1240 x 1240 pixels. Wide-field fundus image from infant ROP screening: 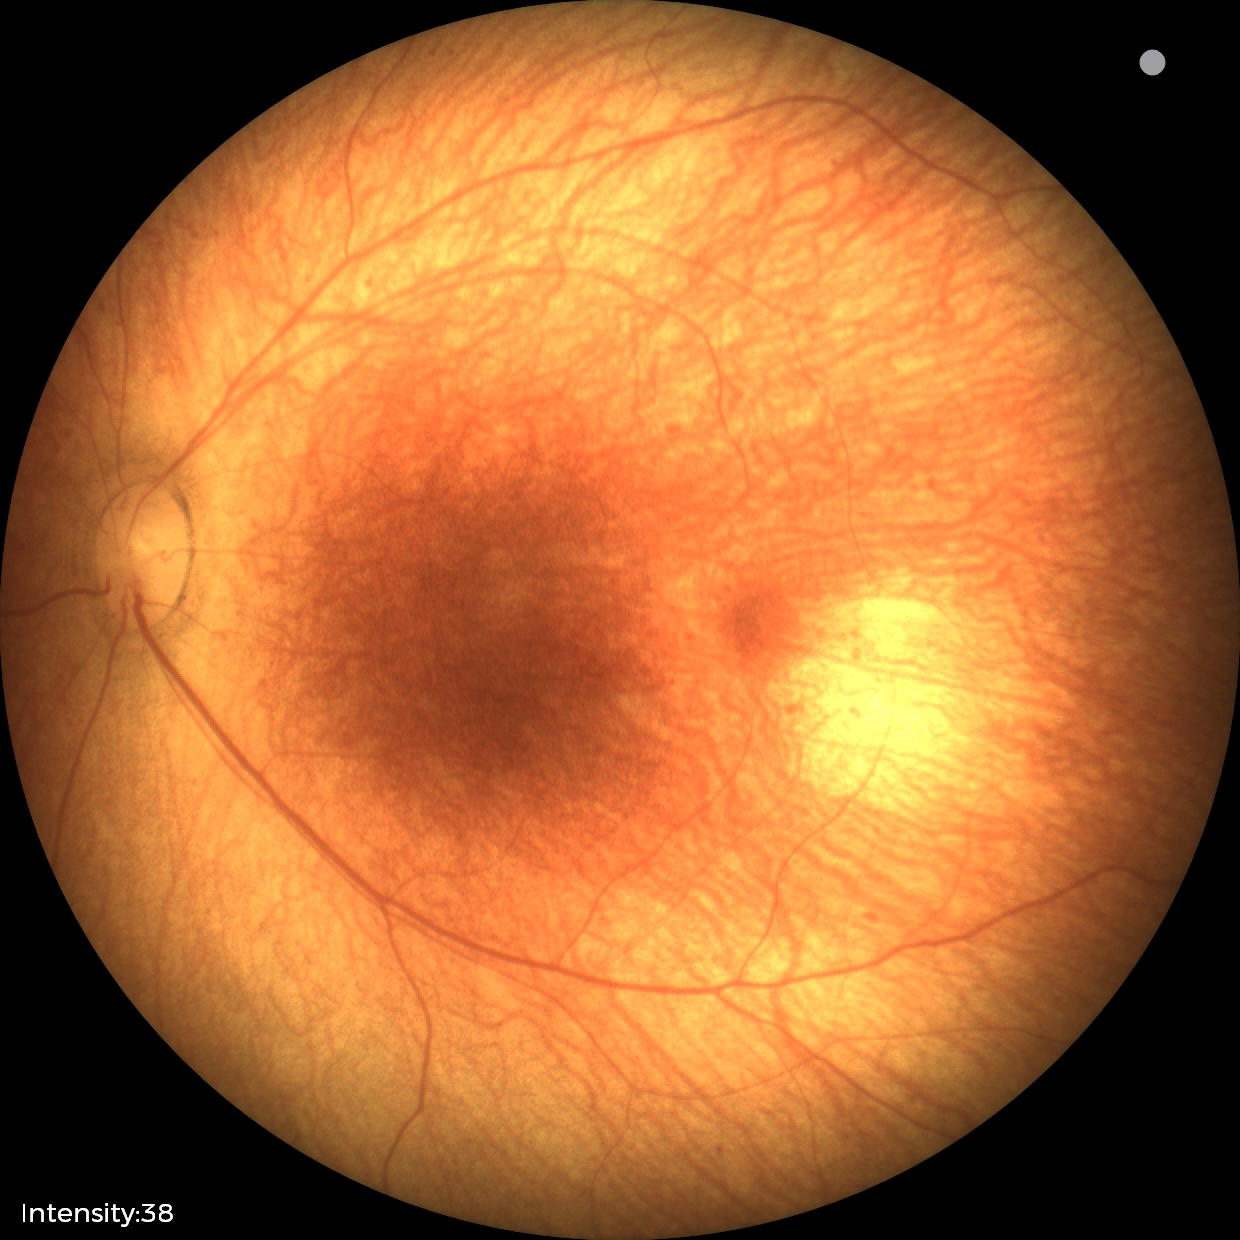

Assessment: physiological appearance with no retinal pathology.